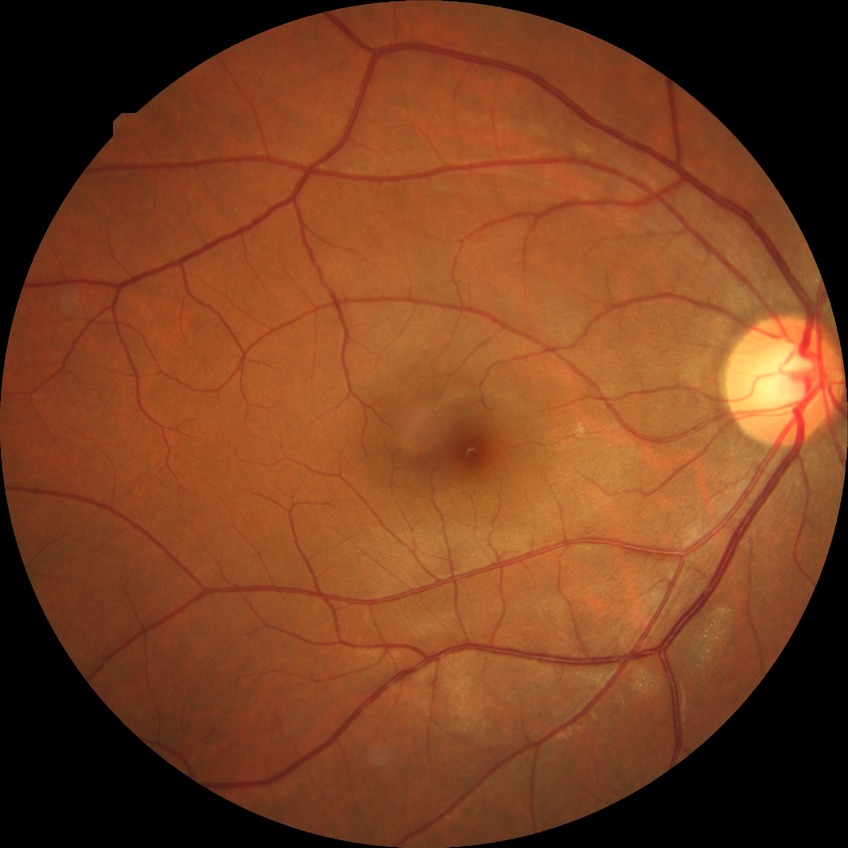 Retinopathy grade: simple diabetic retinopathy. Disease class: non-proliferative diabetic retinopathy.